Camera: Natus RetCam Envision (130° FOV); wide-field fundus photograph of an infant — 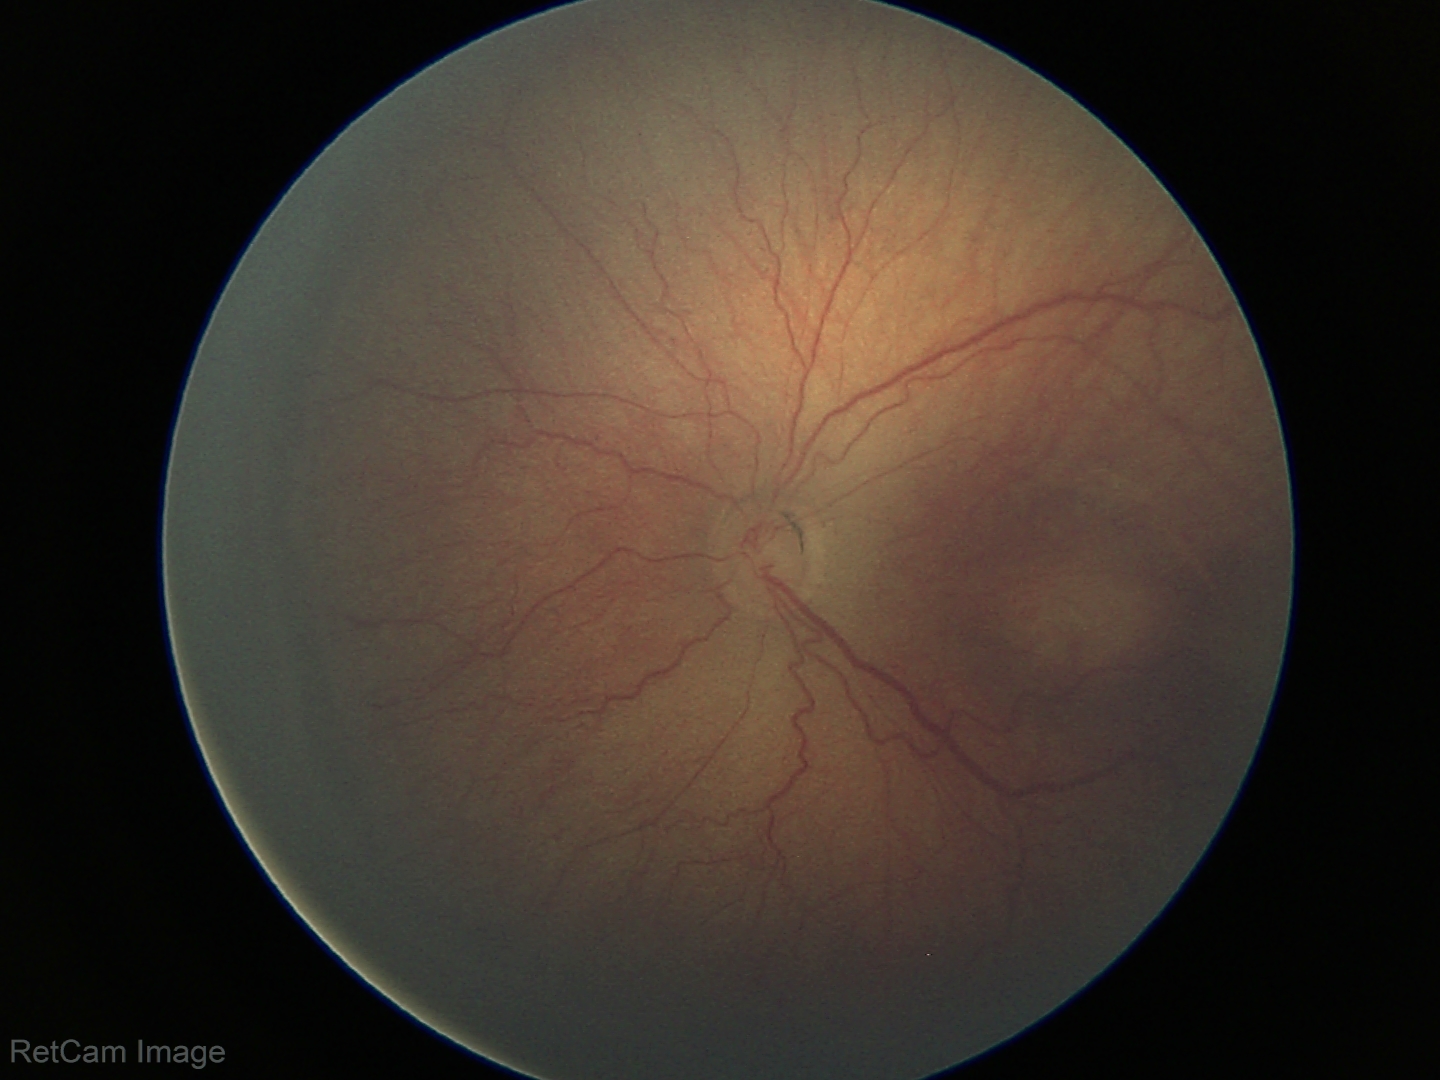

No plus disease.
Screening examination consistent with ROP stage 3.